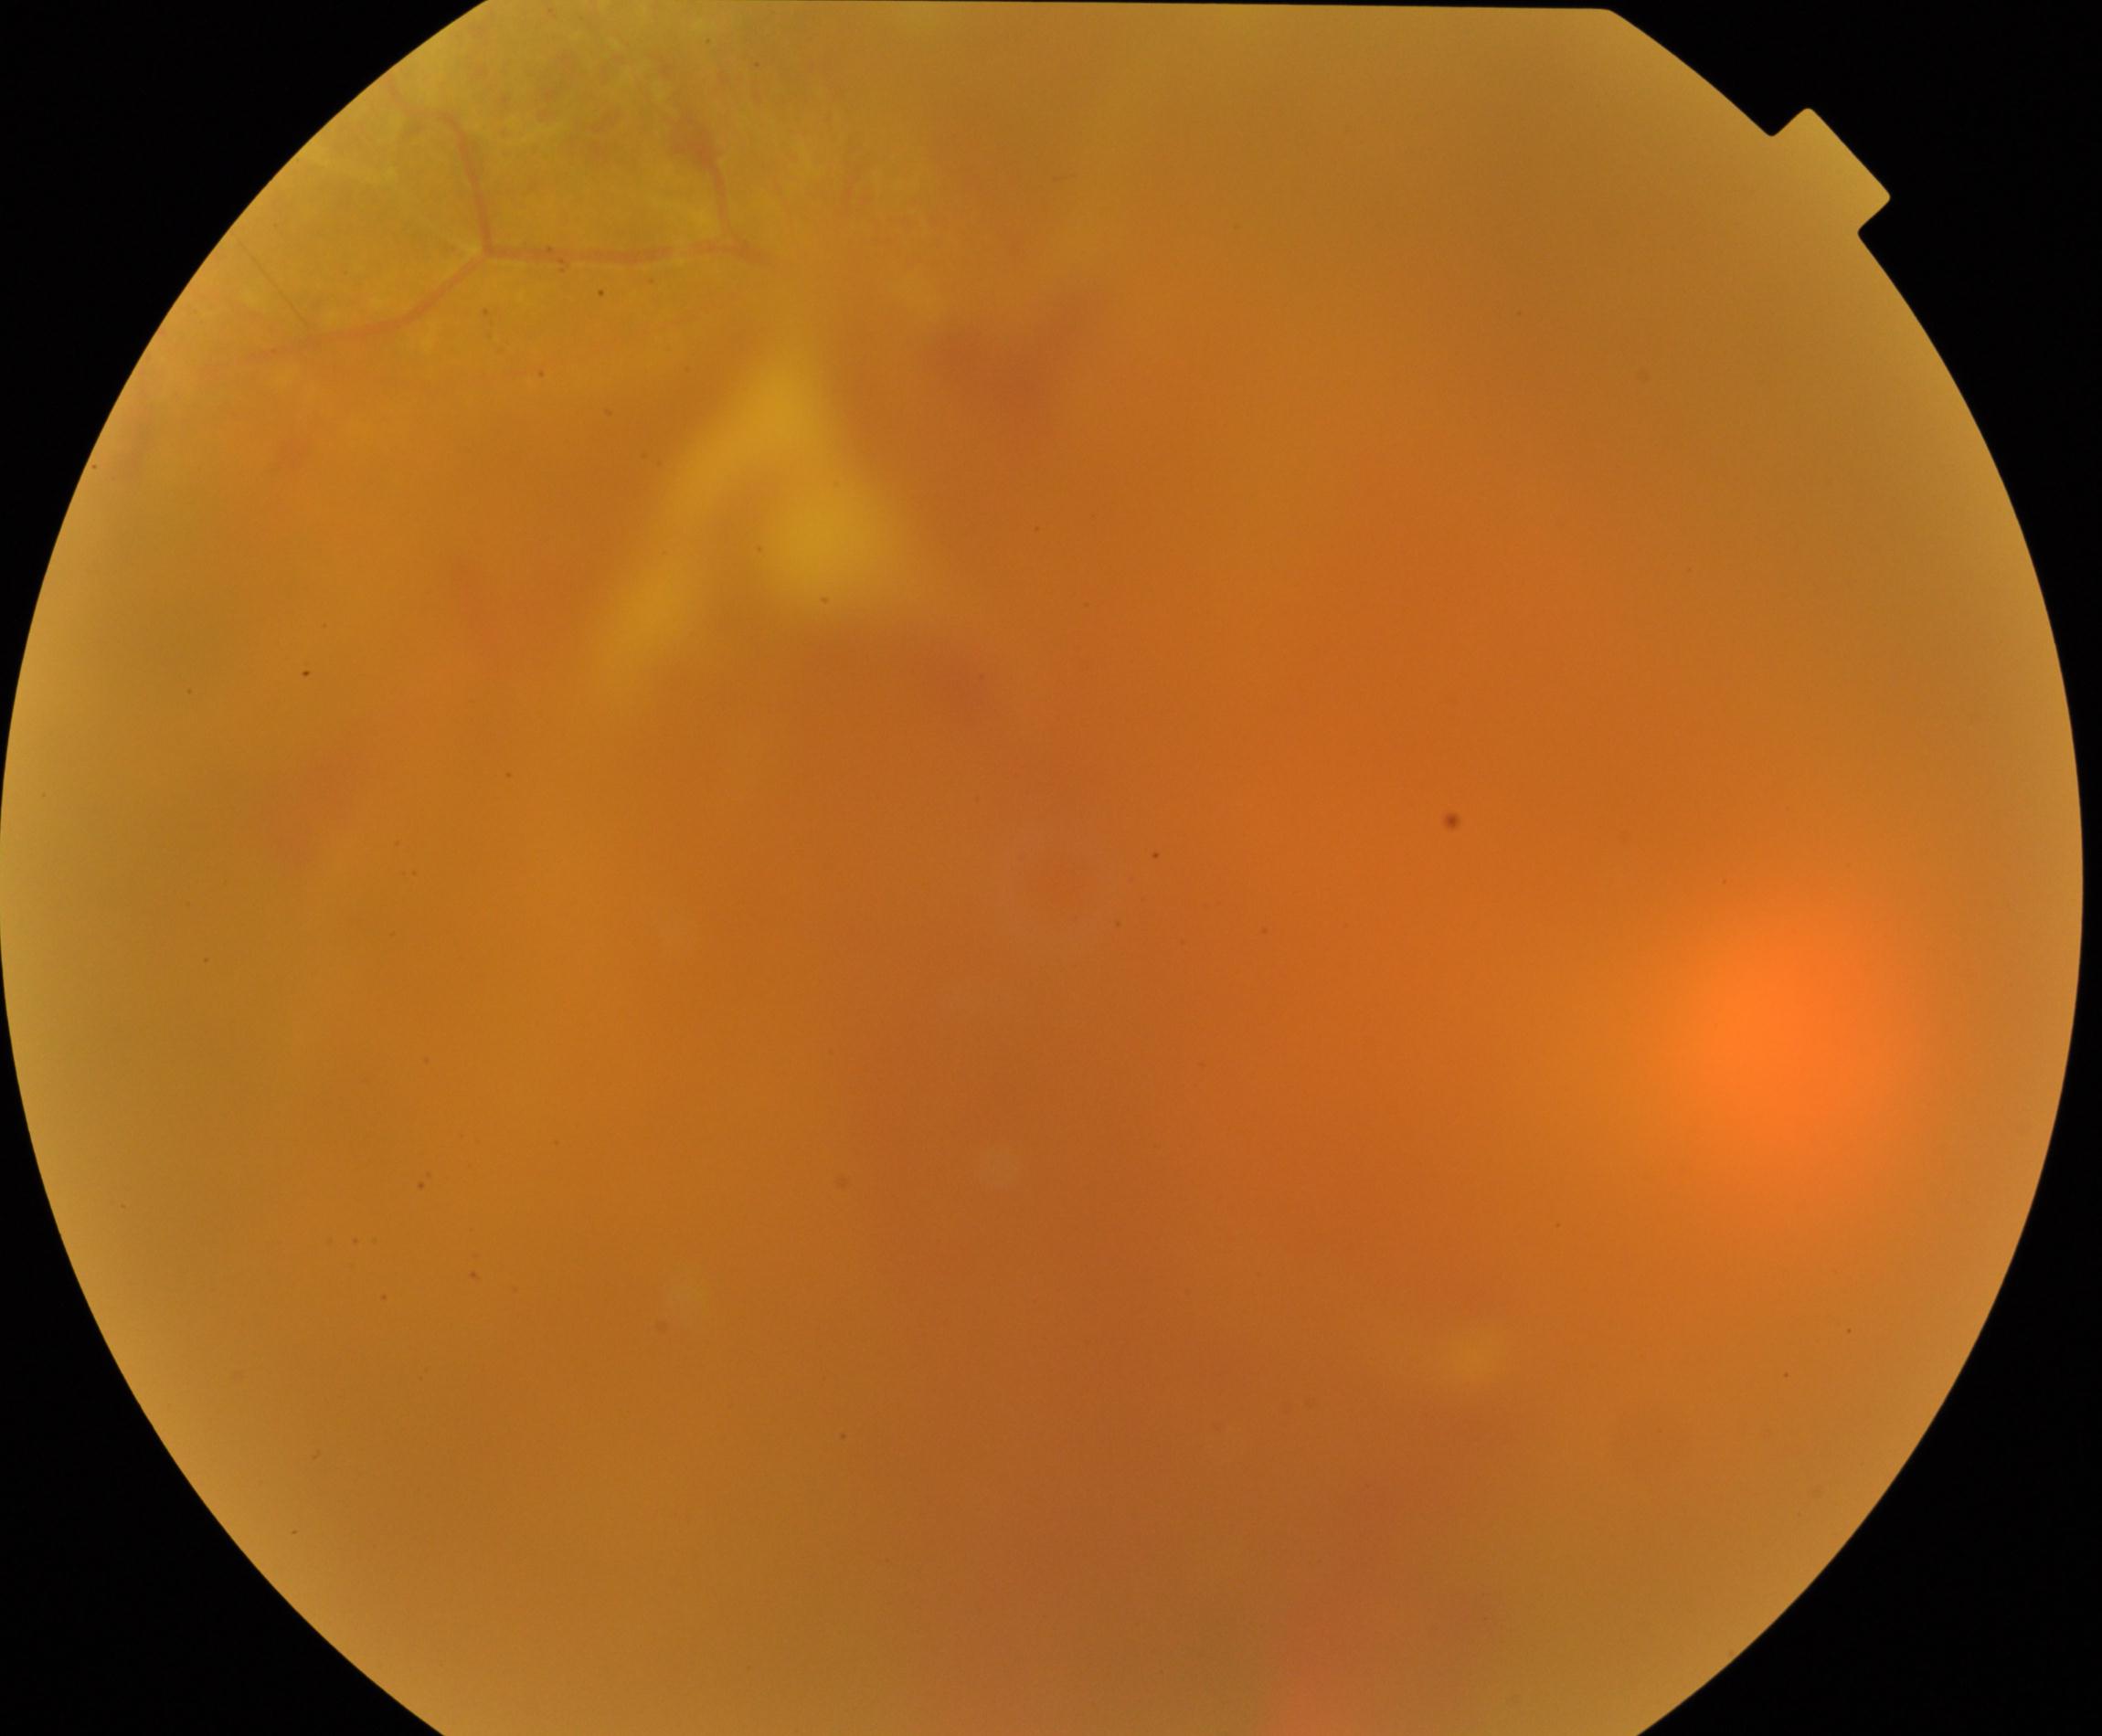

Image is blurred; retinal landmarks are largely obscured. Features suspicious for proliferative diabetic retinopathy.